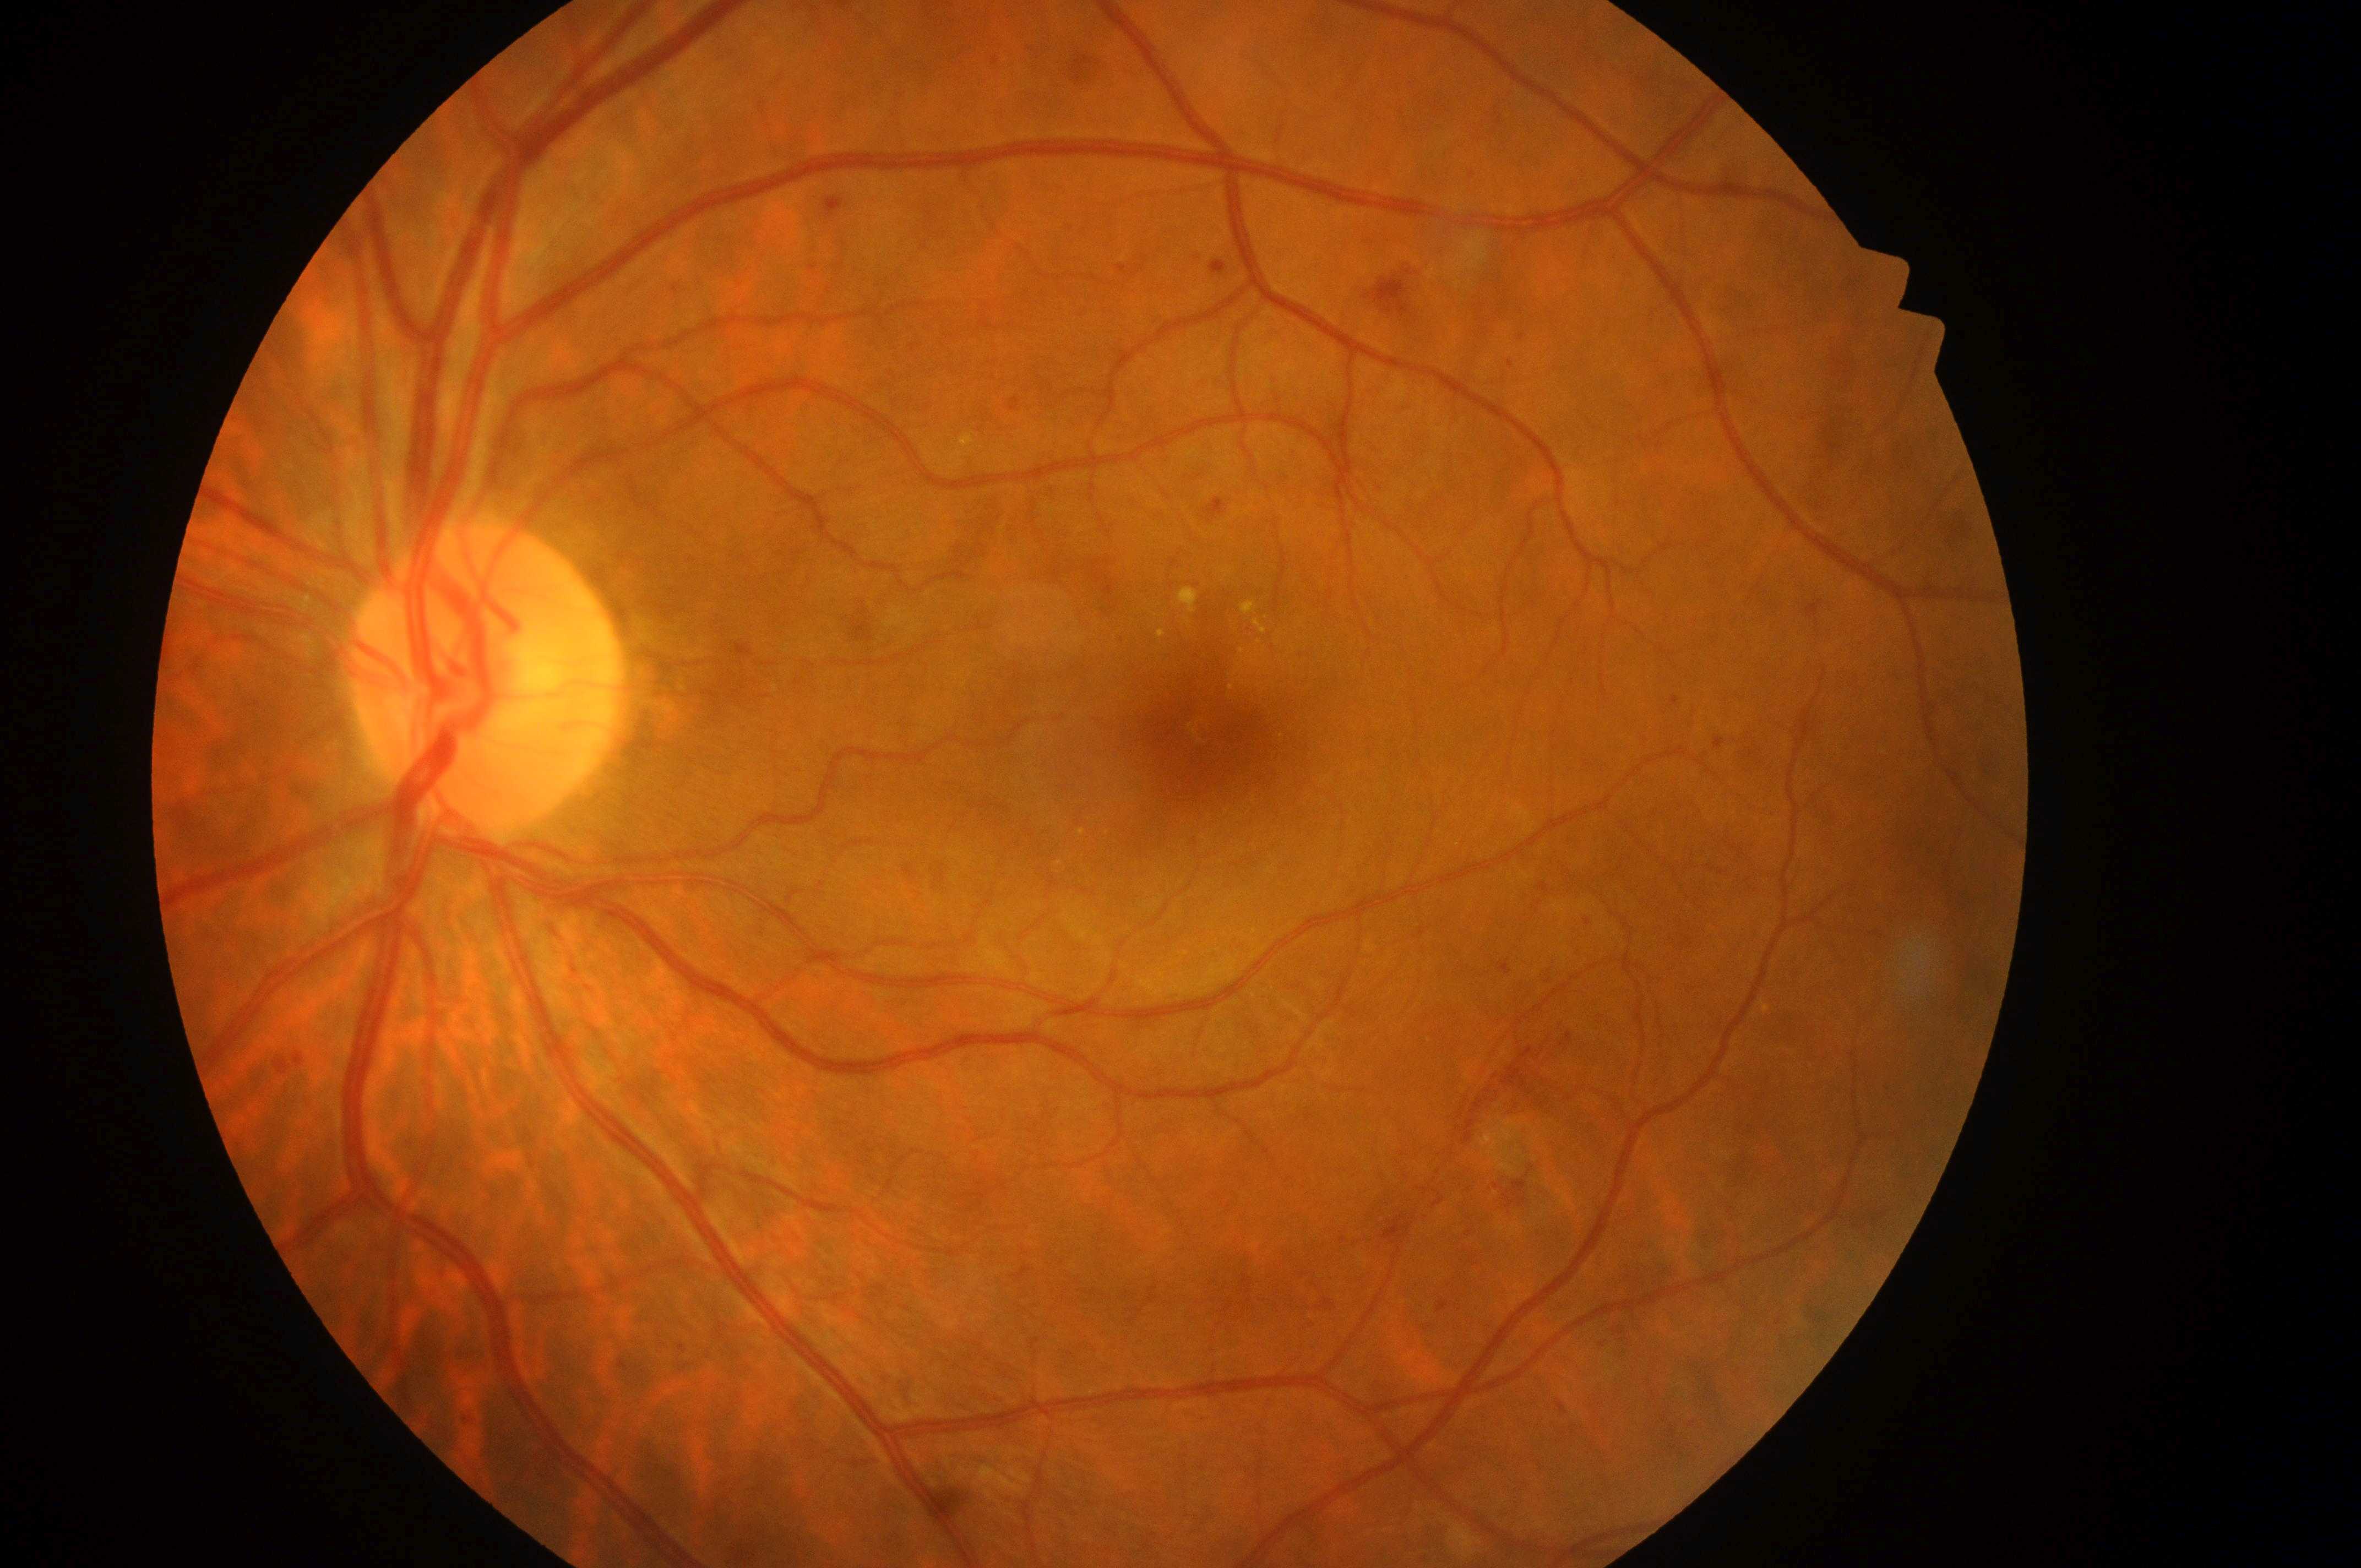
the fovea = 1211, 740 | ONH = 474, 693 | eye = OS | diabetic macular edema = high risk (grade 2) — hard exudates within one disc diameter of the macula center | retinopathy grade = 3 (severe NPDR) — more than 20 intraretinal hemorrhages in each of 4 quadrants, definite venous beading in 2 or more quadrants, or prominent intraretinal microvascular abnormalities in 1 or more quadrants, with no signs of proliferative retinopathy | DR class = non-proliferative diabetic retinopathy.